NIDEK AFC-230 · CFP.
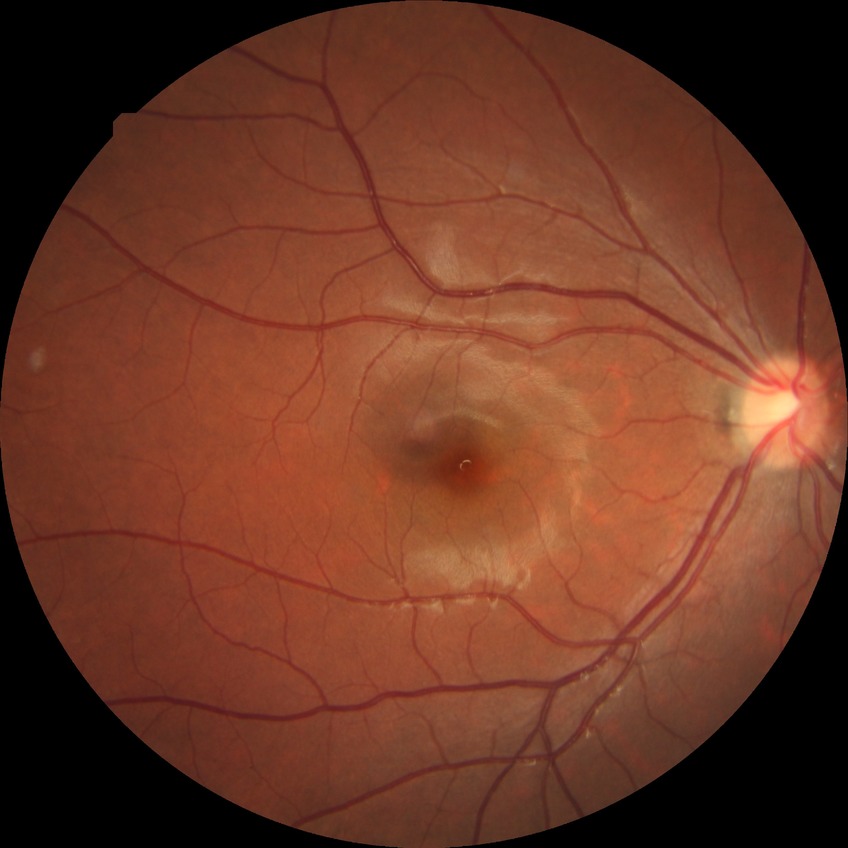 DR stage: NDR.